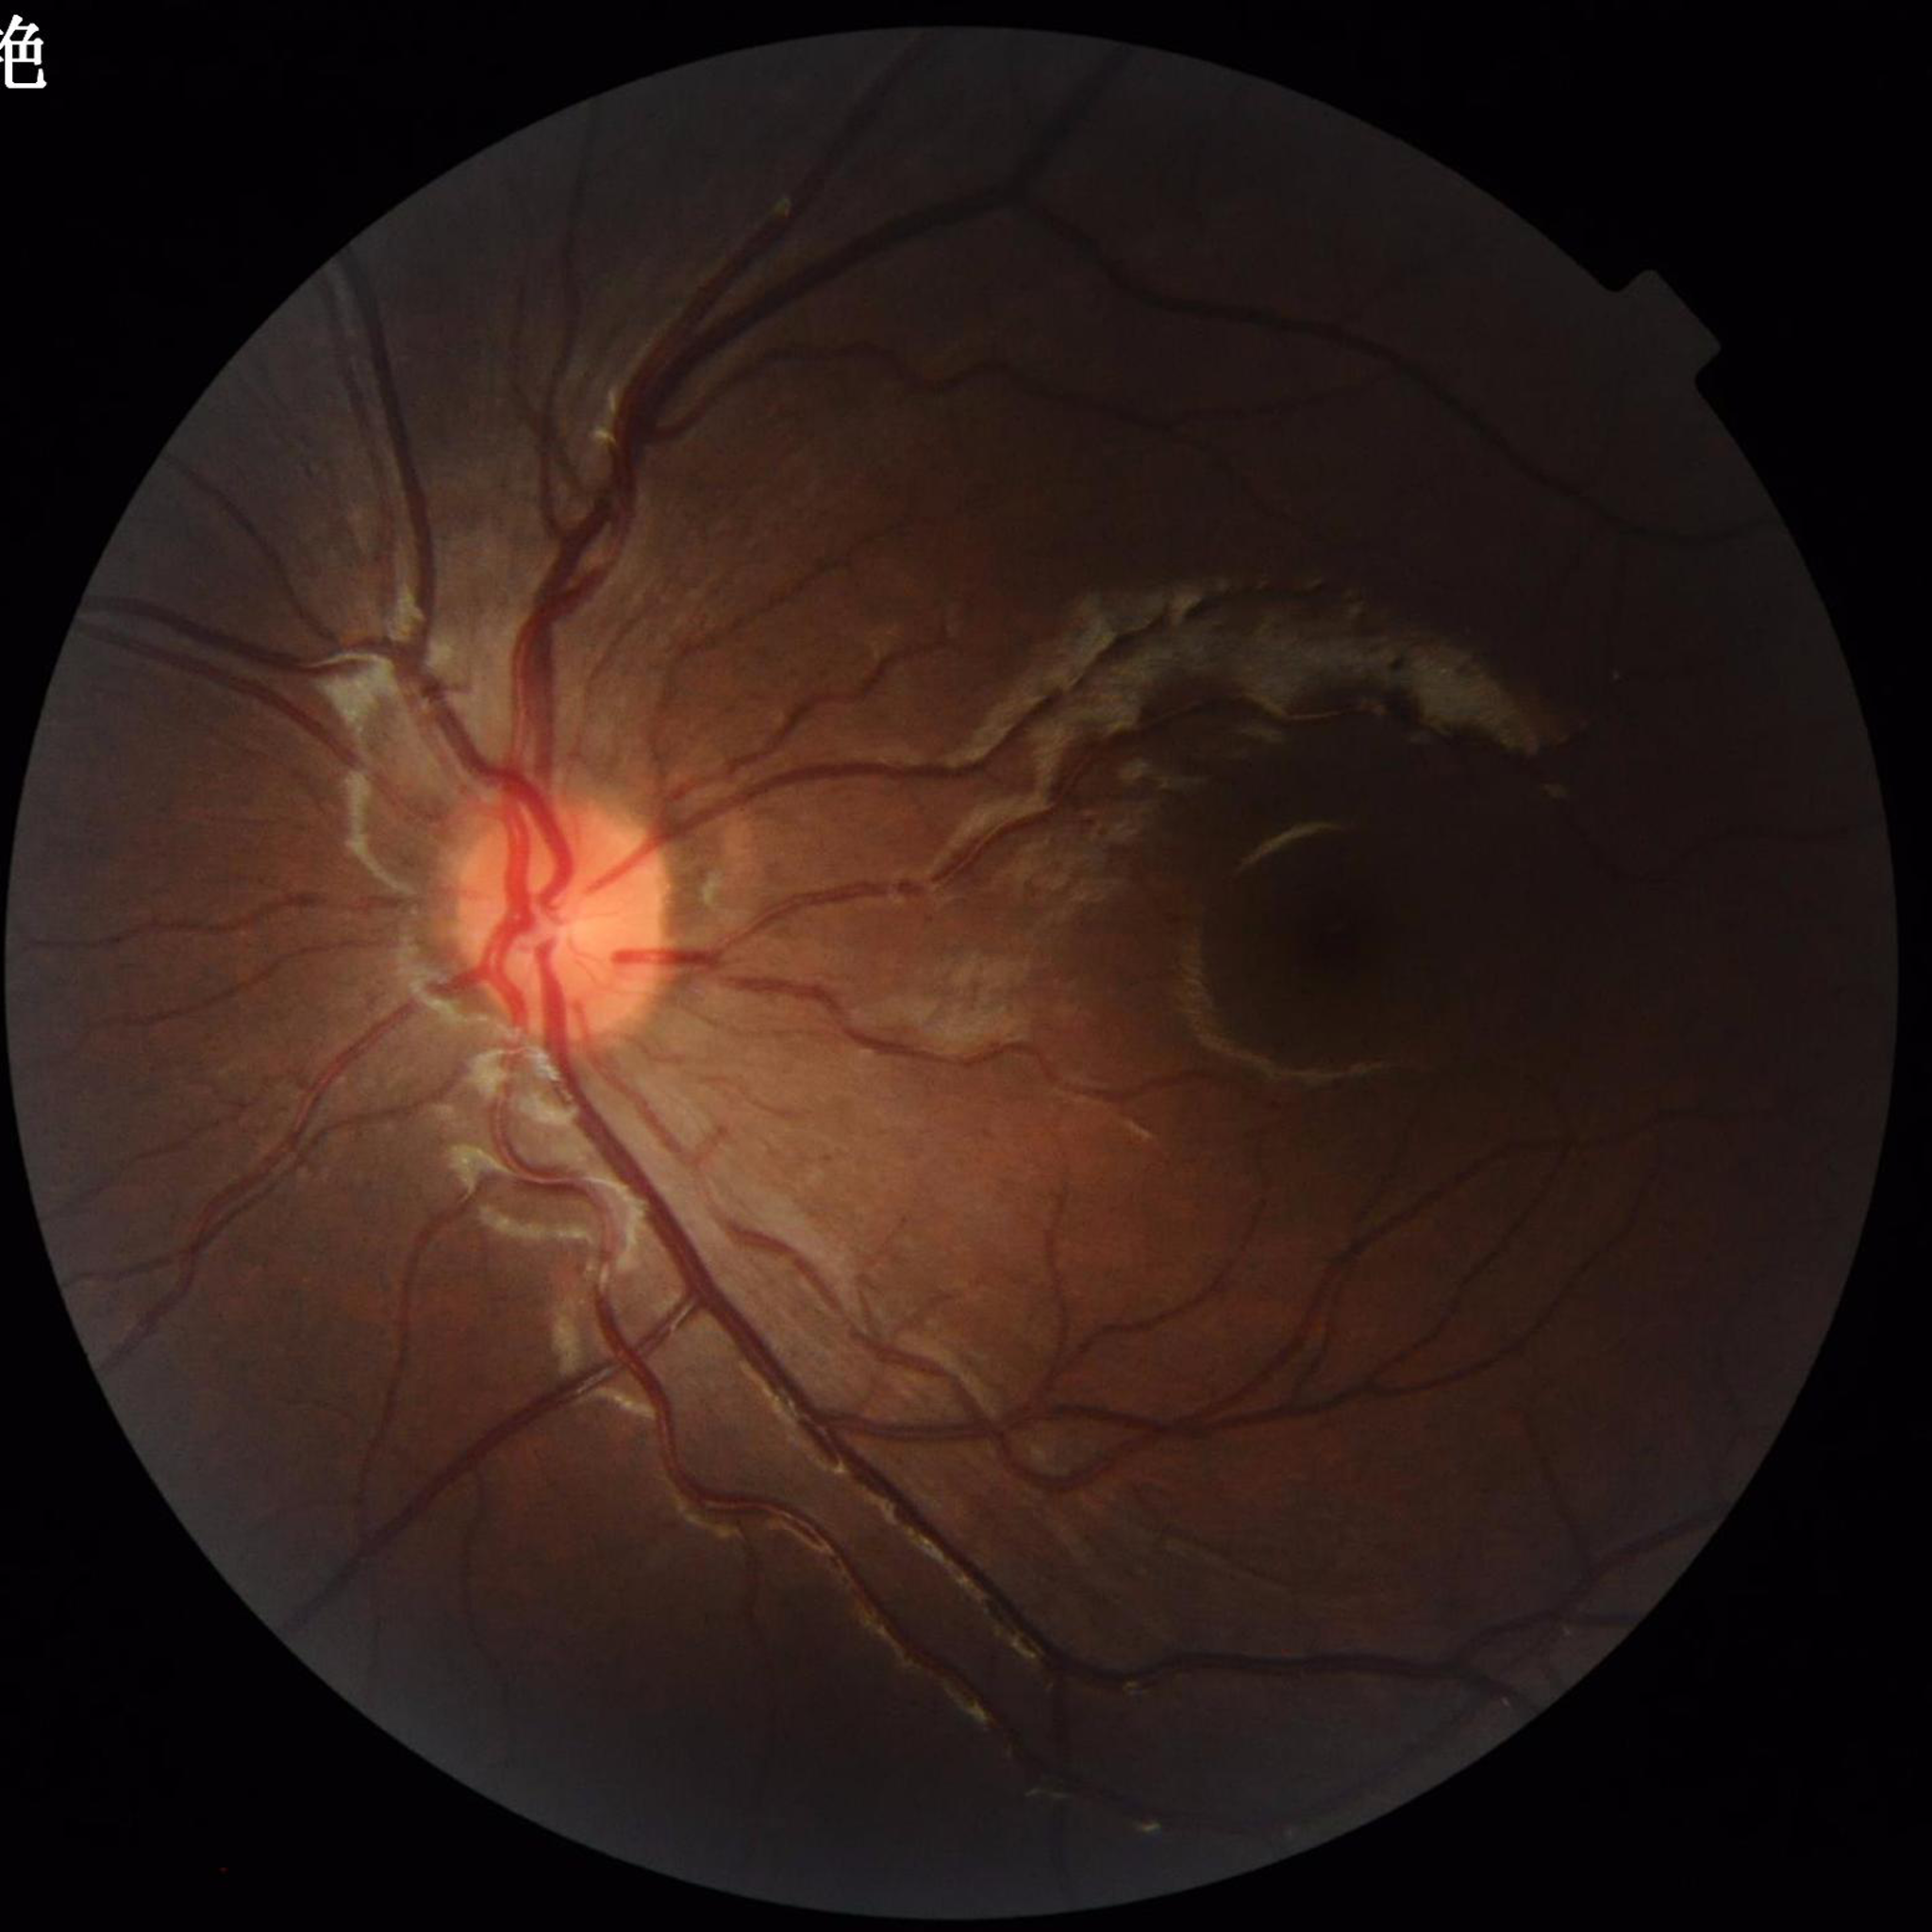 diagnosis: no AMD, diabetic retinopathy, or glaucoma